Without pupil dilation; NIDEK AFC-230 fundus camera; fundus photo — 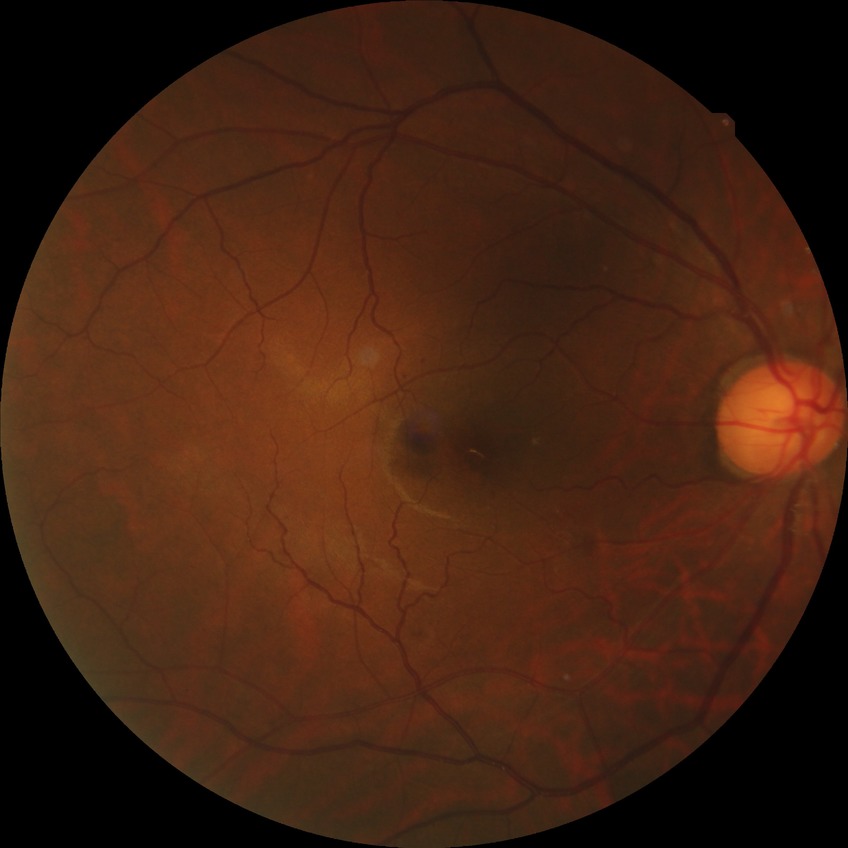 DR severity@SDR.